Davis DR grading: 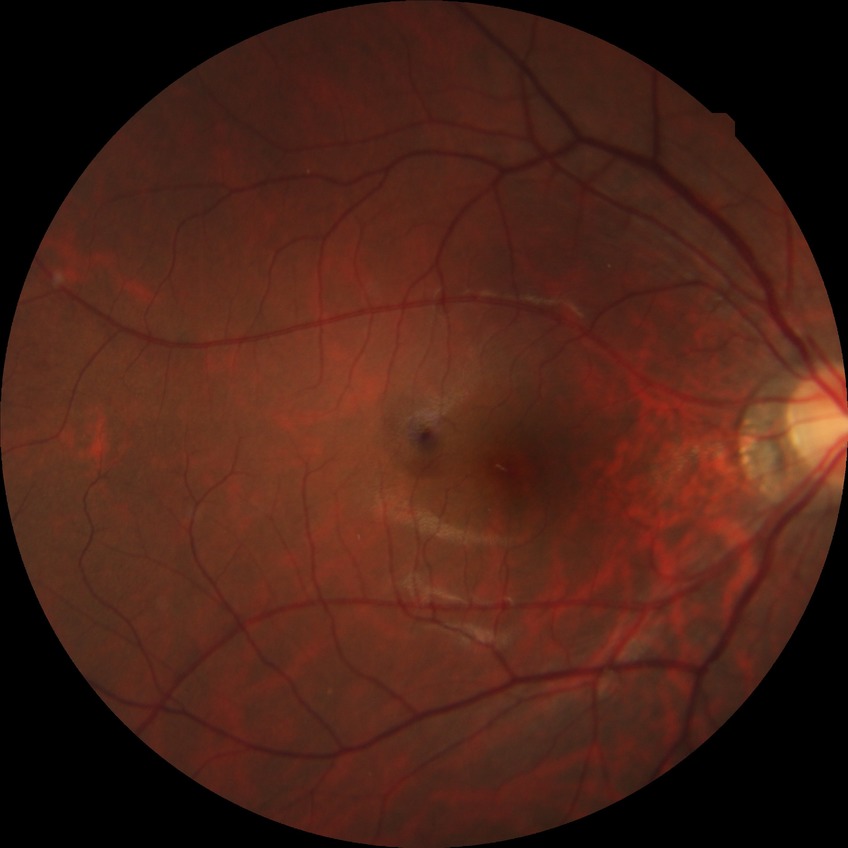

Annotations:
– diabetic retinopathy grade — no diabetic retinopathy